640 x 480 pixels · infant wide-field retinal image: 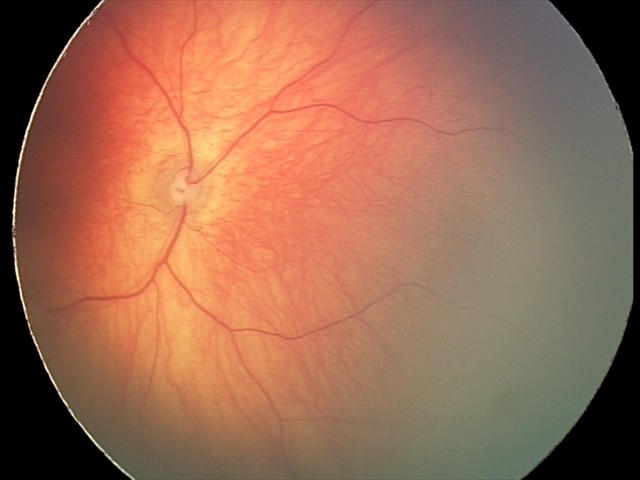
No retinal pathology identified on screening.